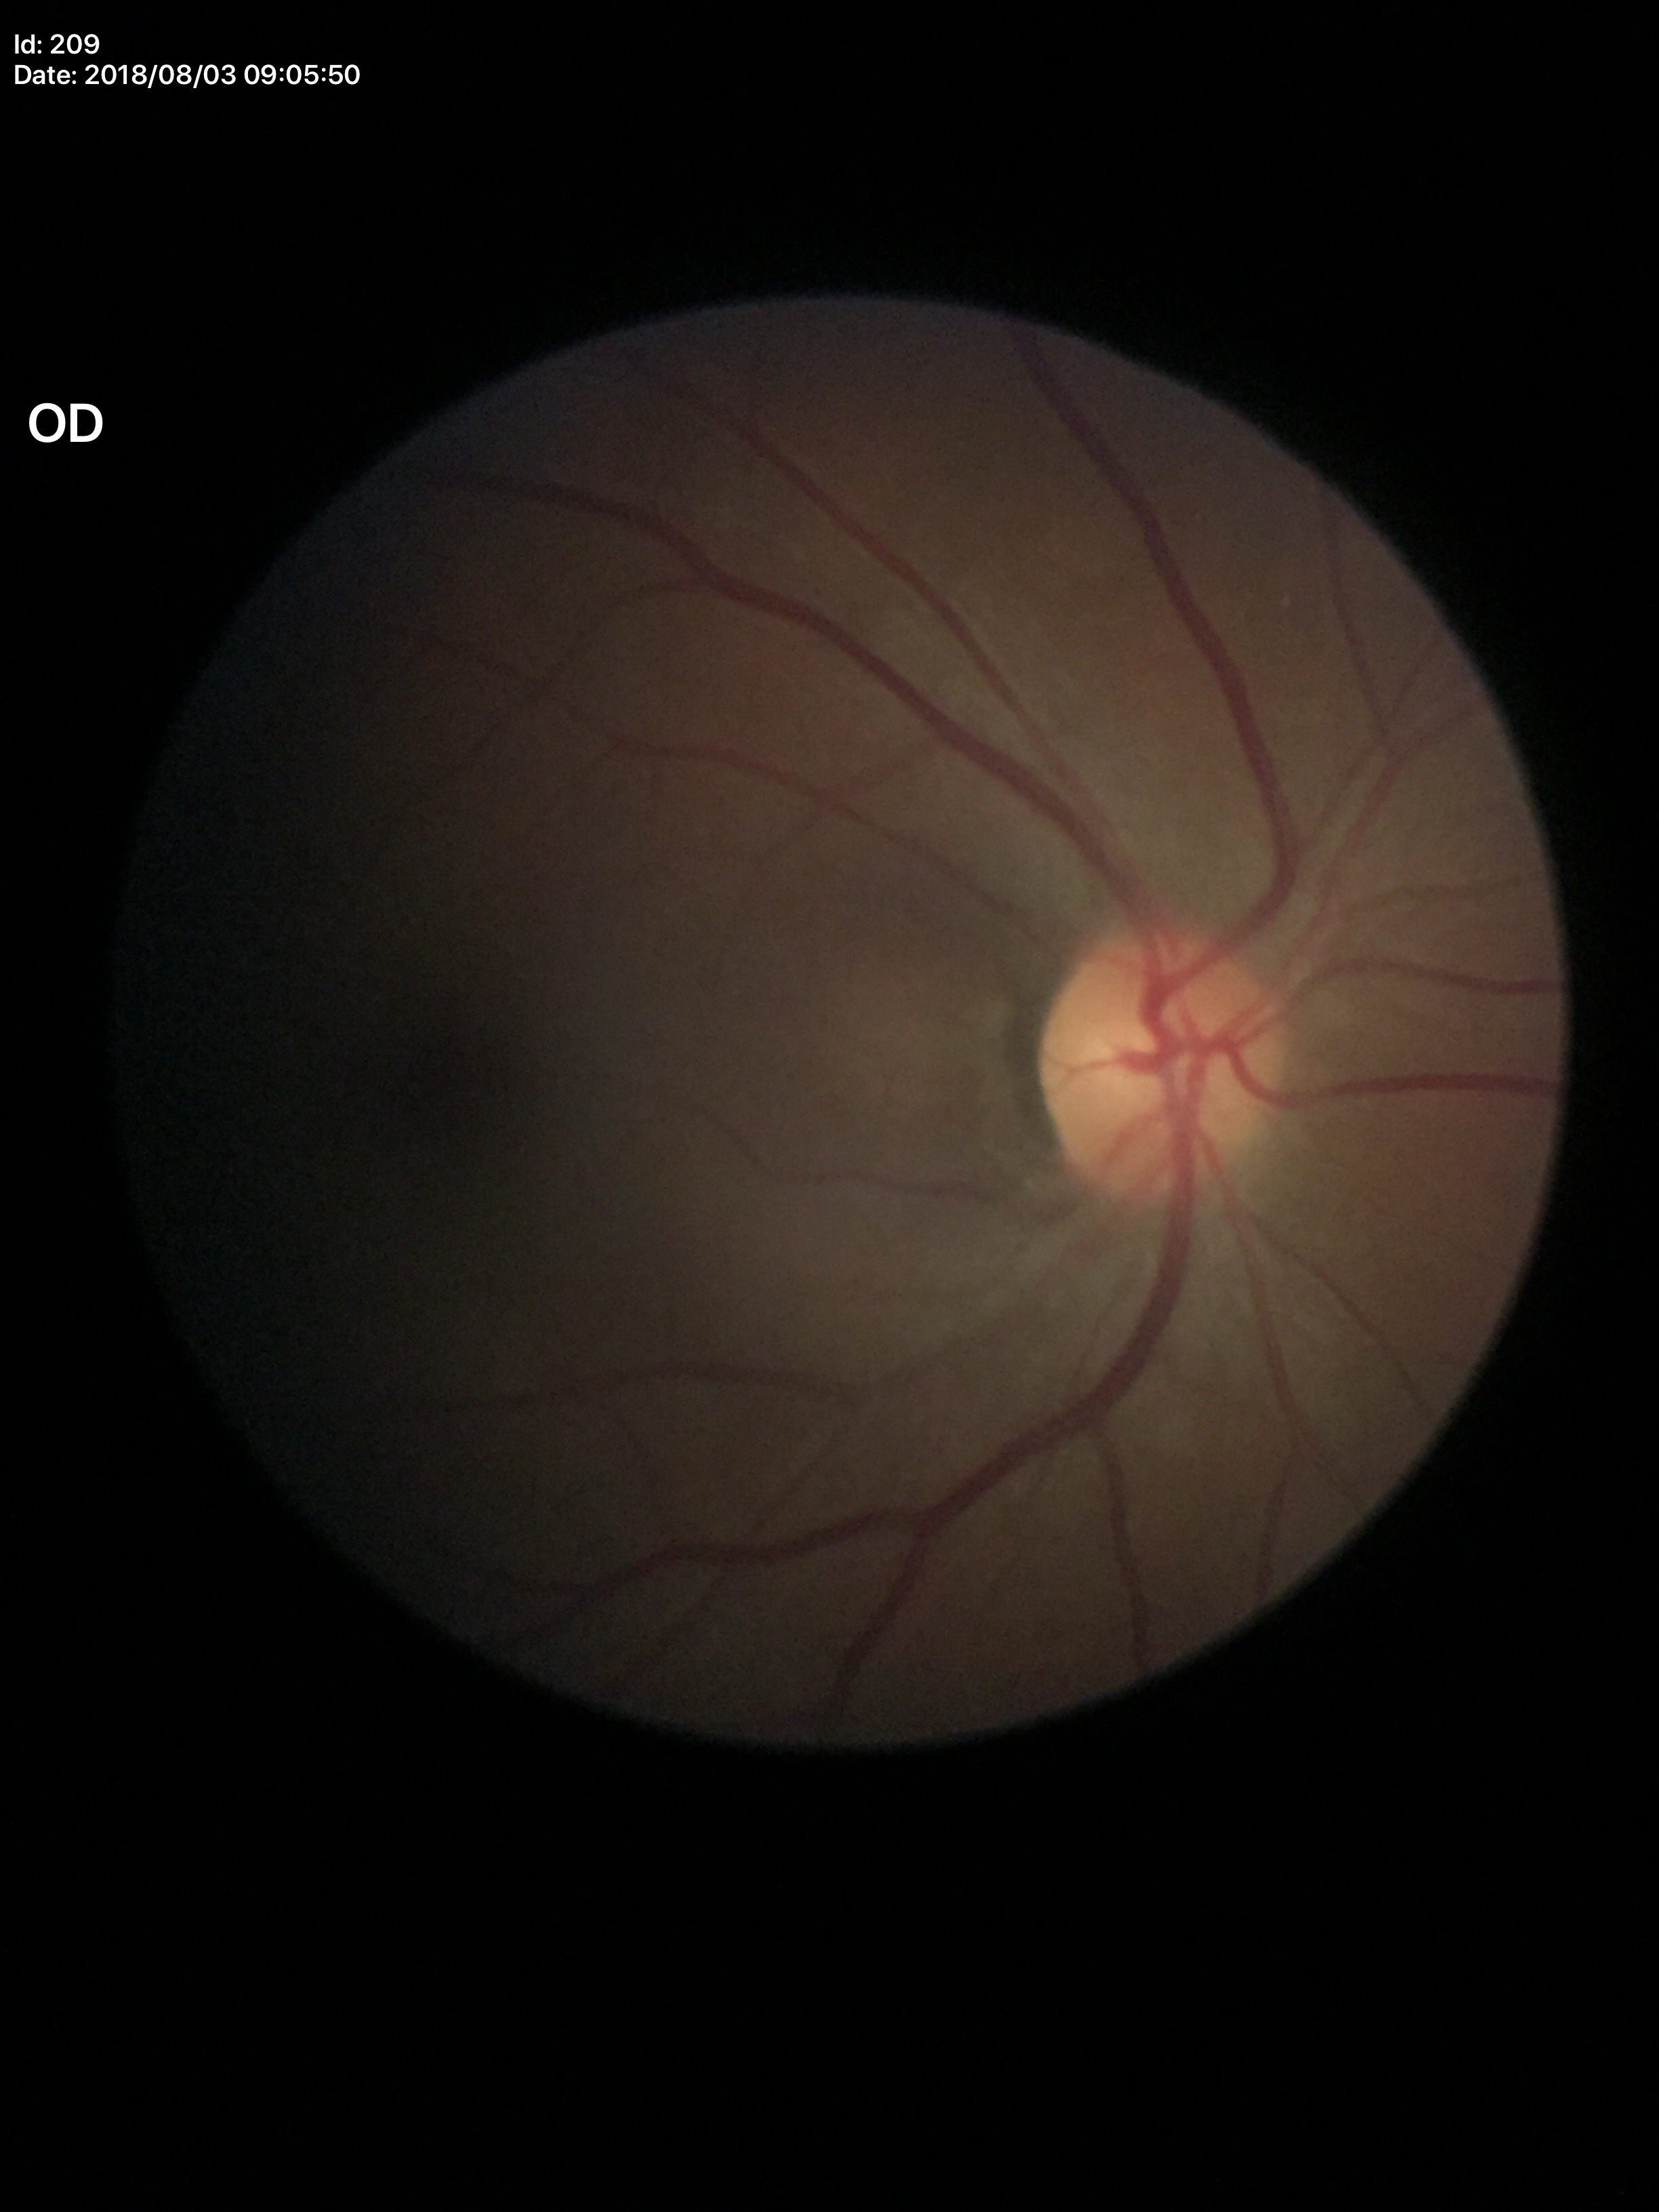 Glaucoma decision=negative (all 5 graders called normal) | vertical CDR (VCDR)=0.37 | horizontal CDR (HCDR)=0.39